CFP:
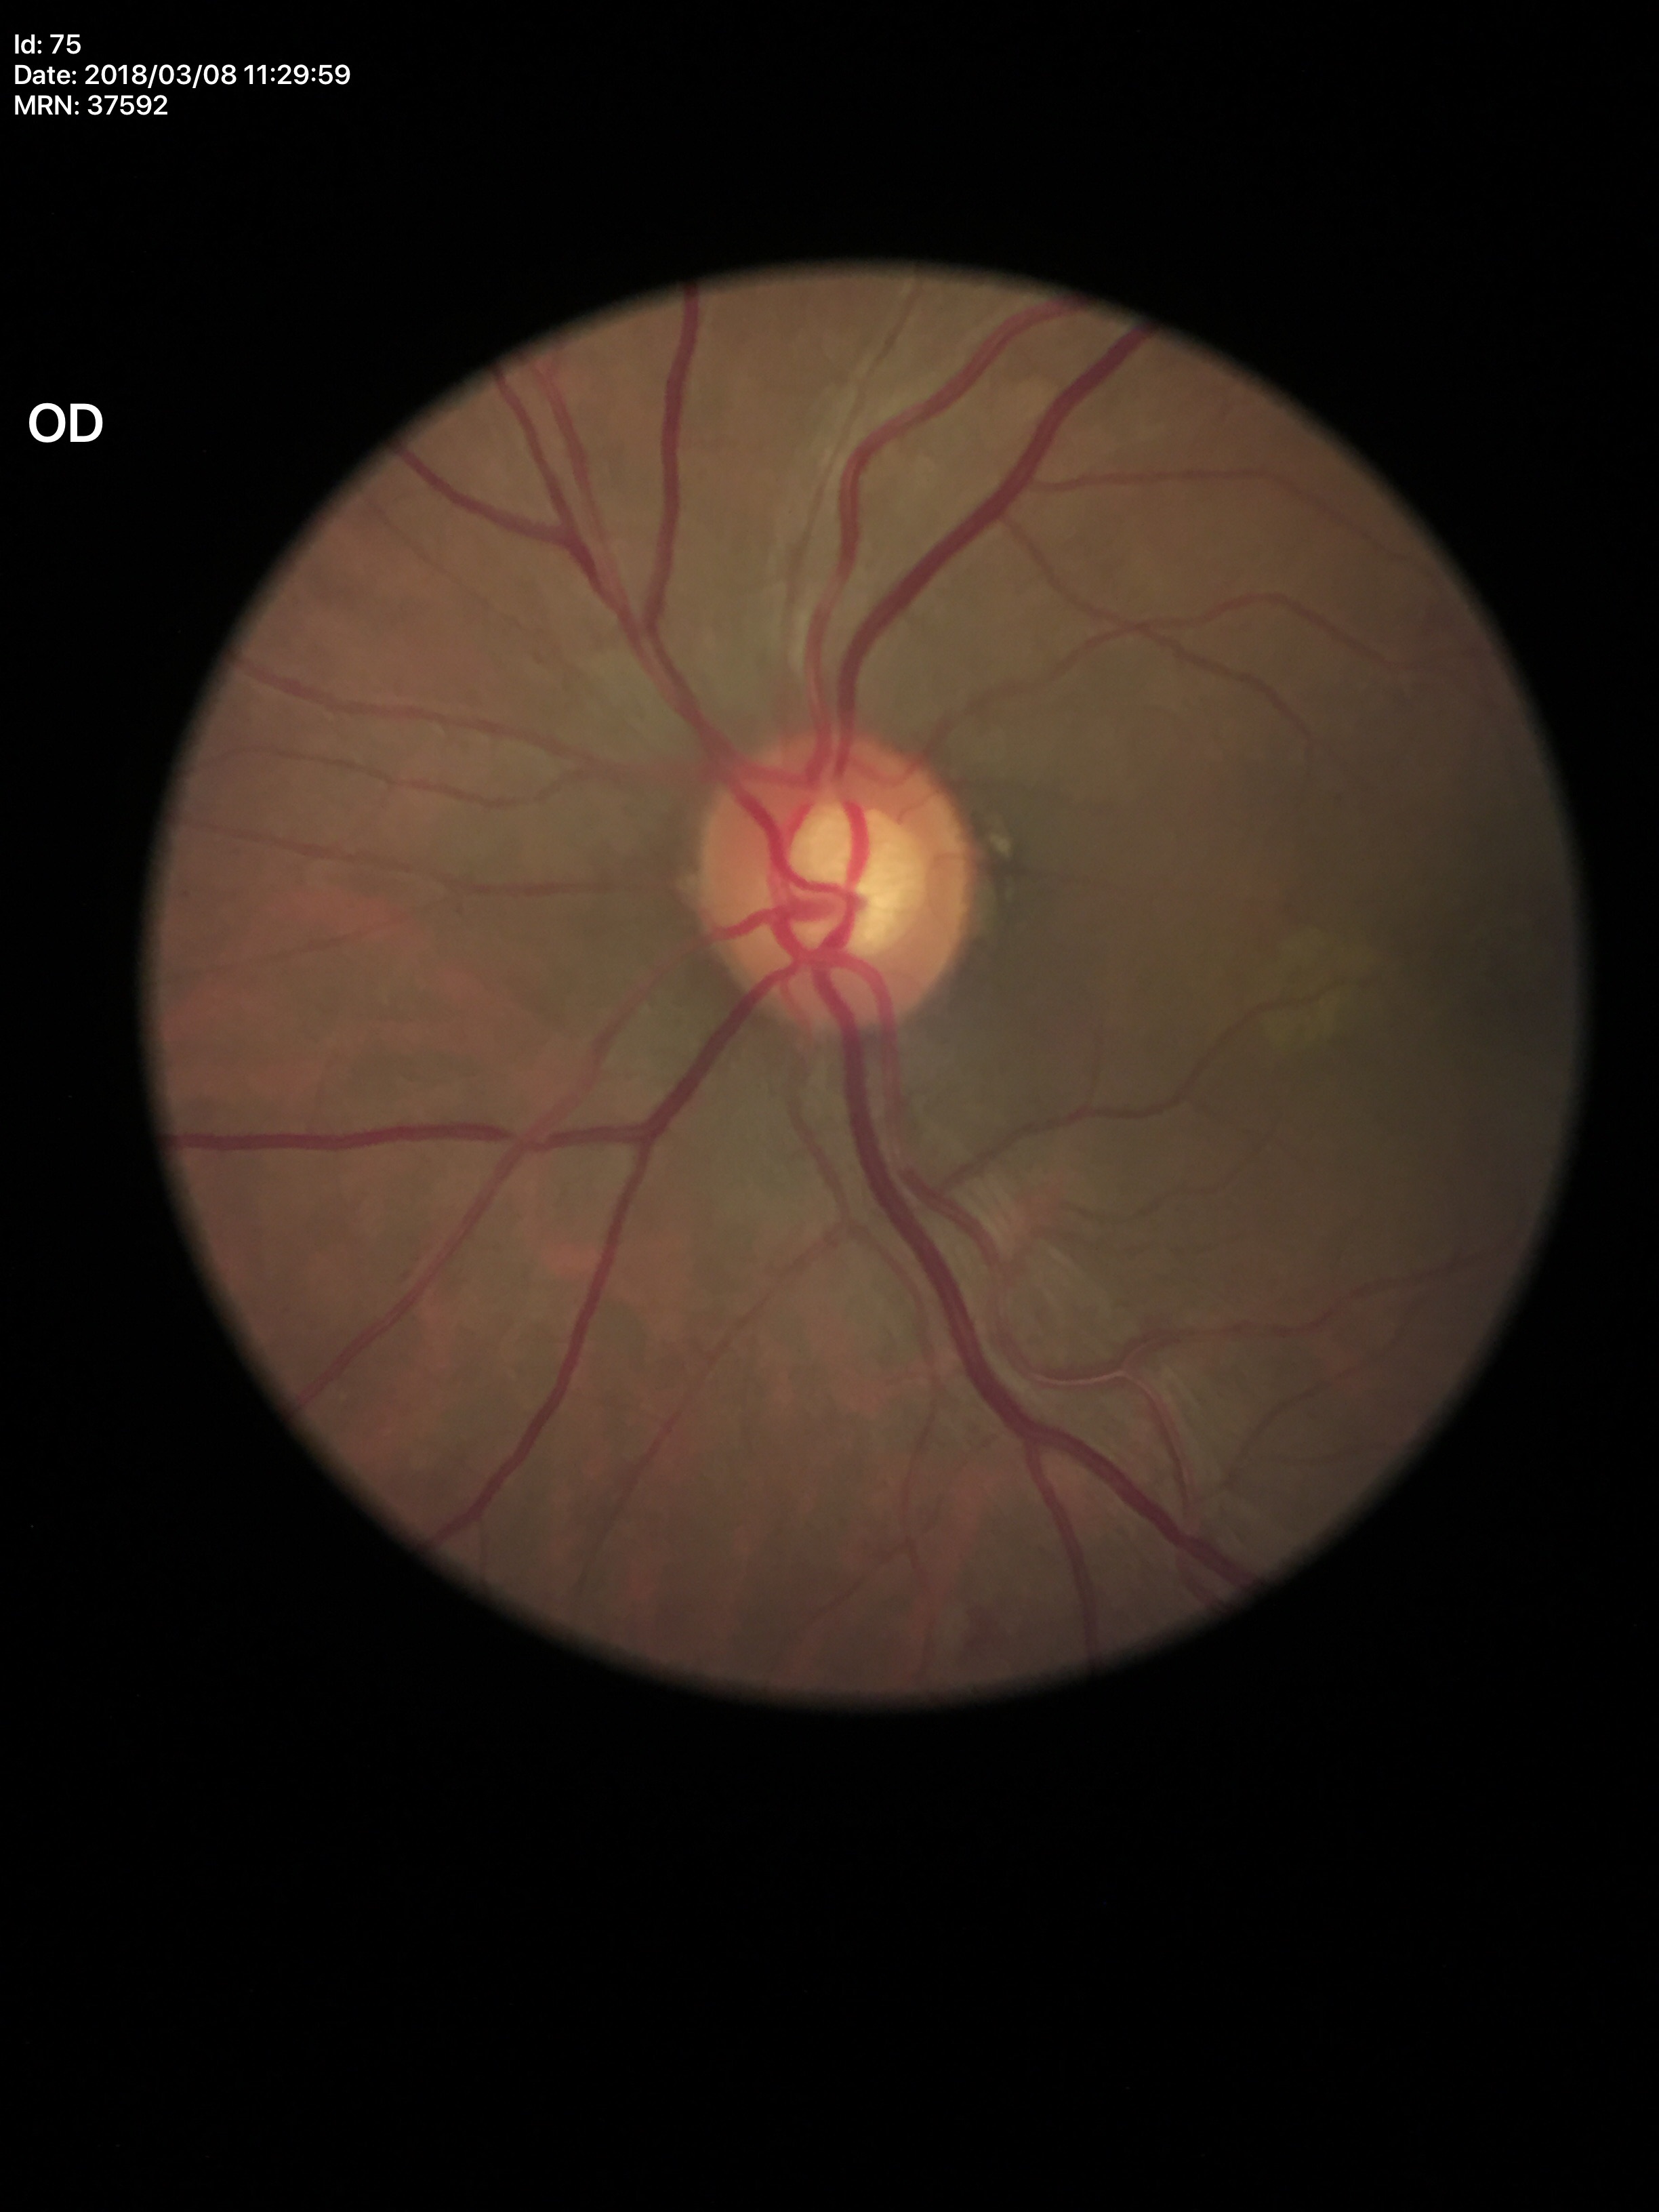
Glaucoma screening impression: no suspicious findings (one of five ophthalmologists flagged glaucoma suspect) | vertical cup-to-disc ratio (VCDR): 0.57 | area cup-to-disc ratio (ACDR): 0.36